Image size 2212x1659 — 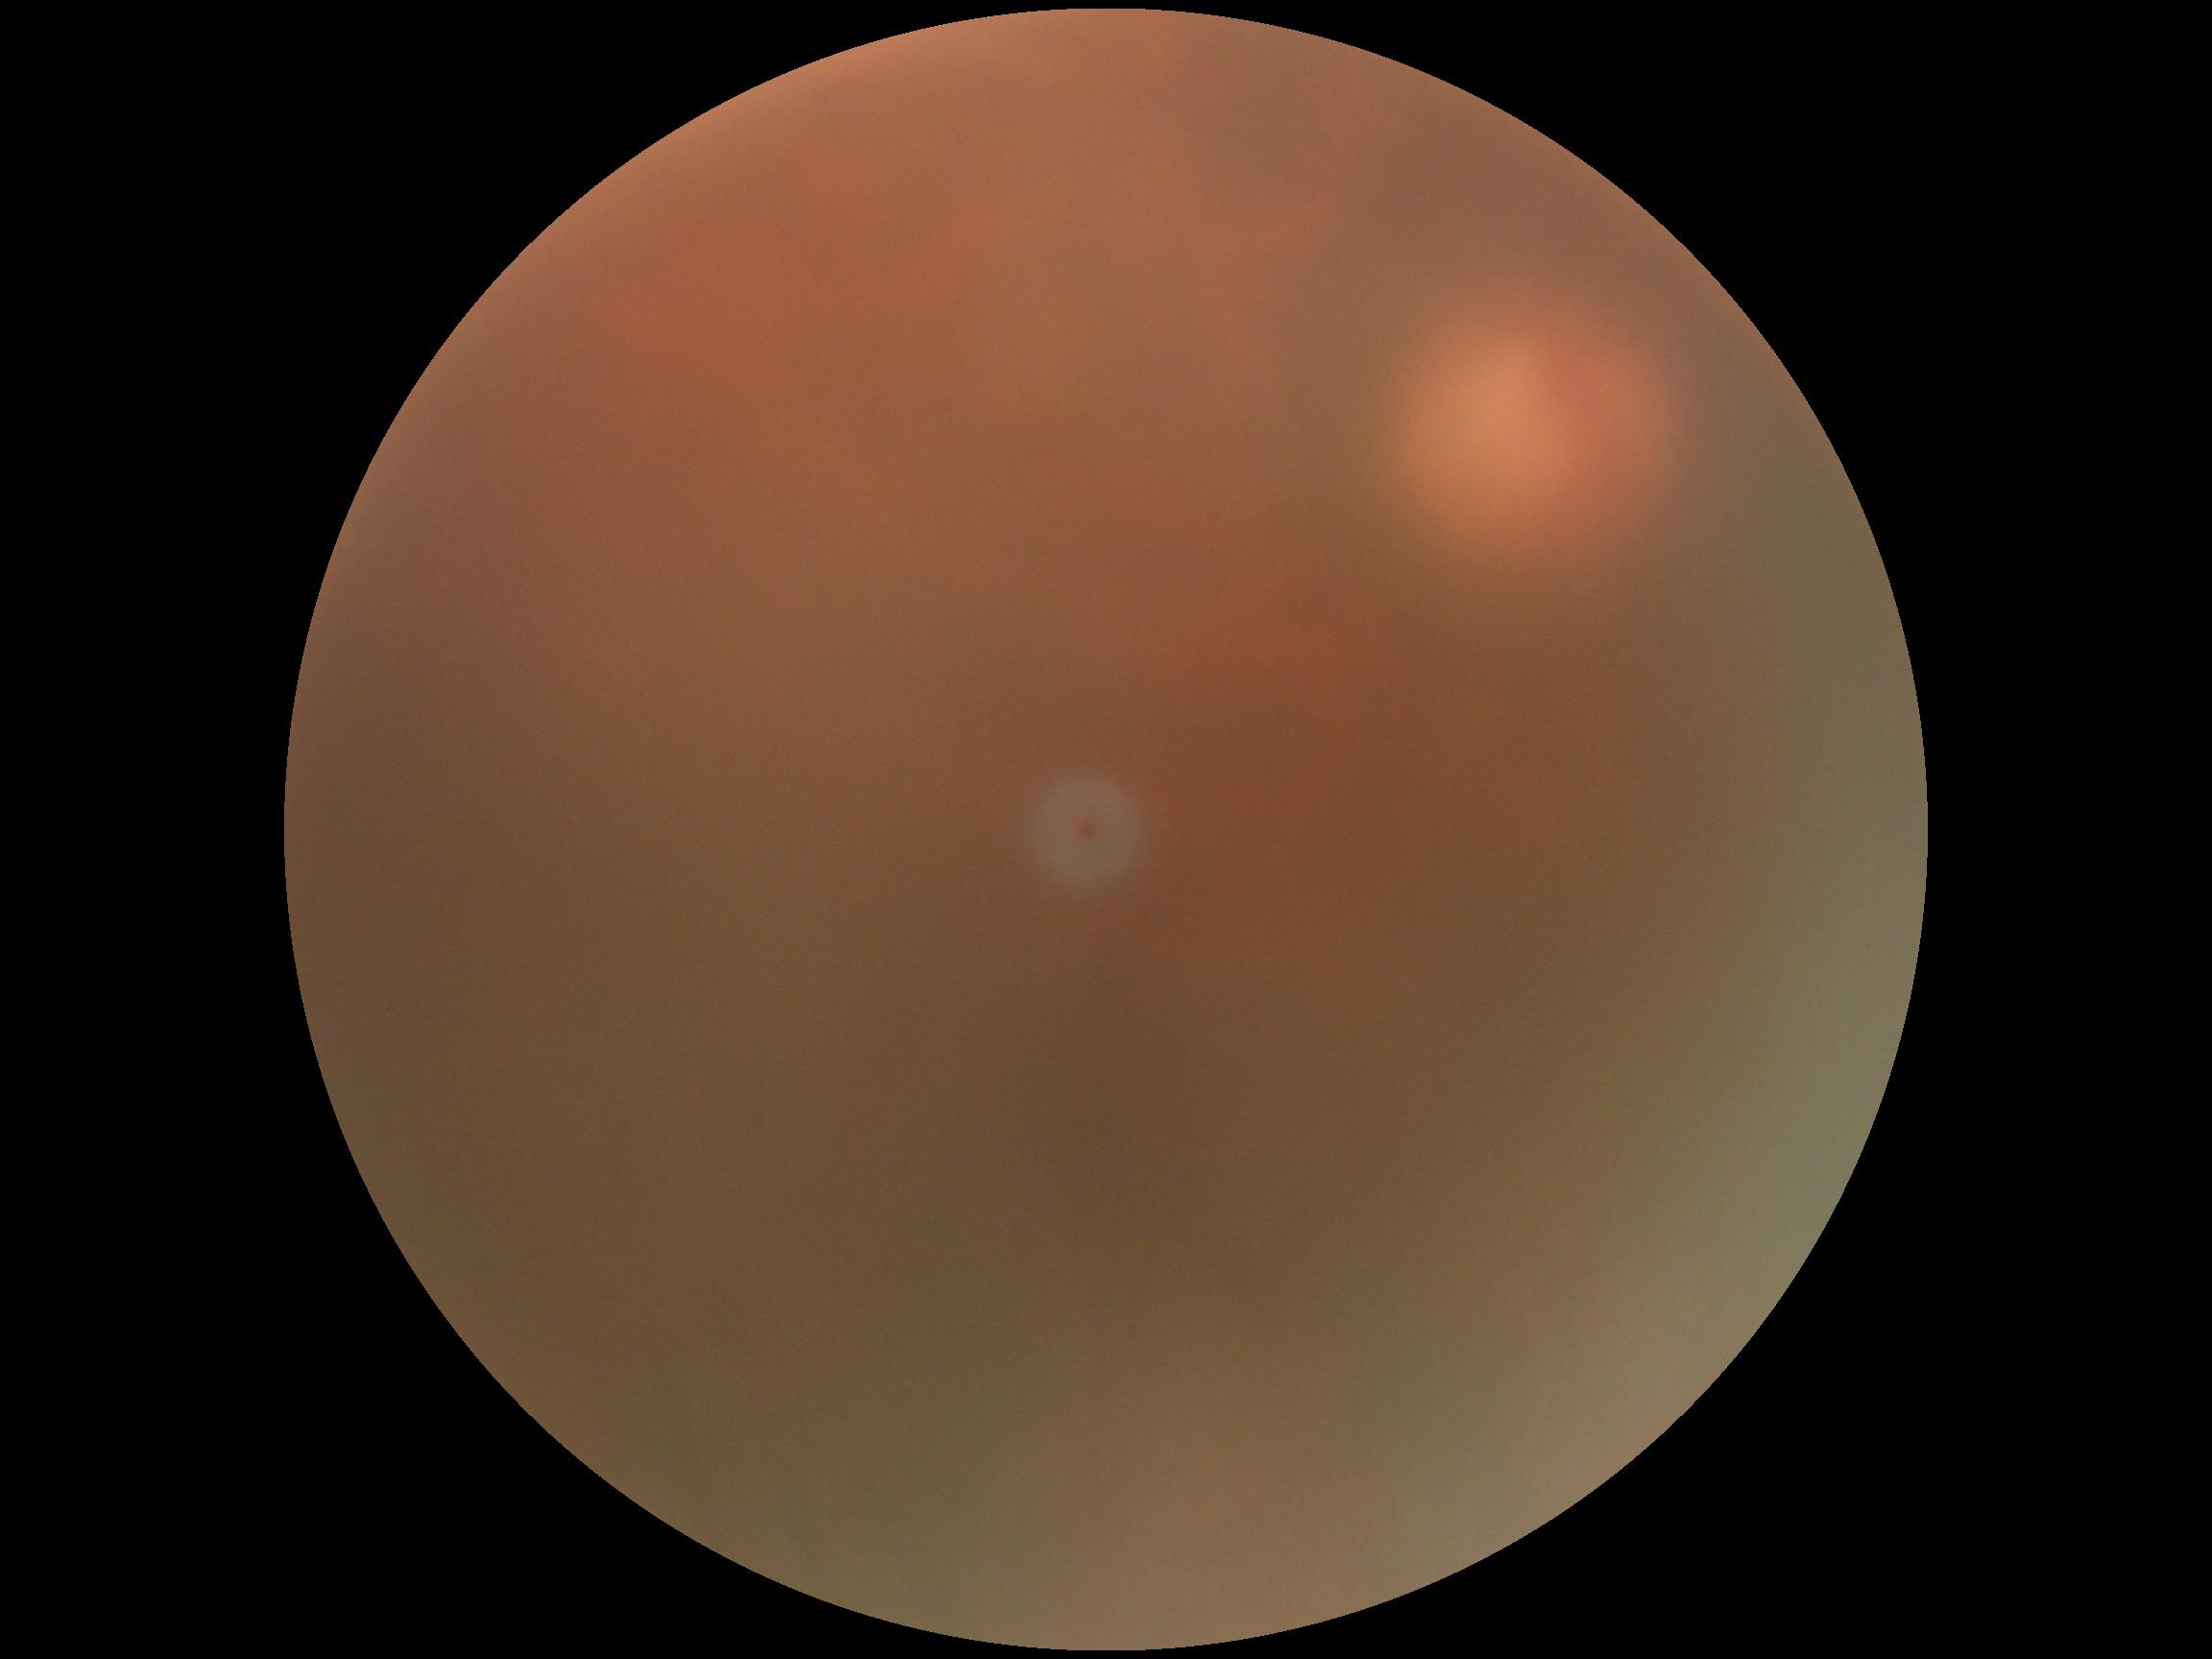
DR grade: ungradable due to poor image quality.